Color fundus photograph; FOV: 45 degrees; 2352 x 1568 pixels.
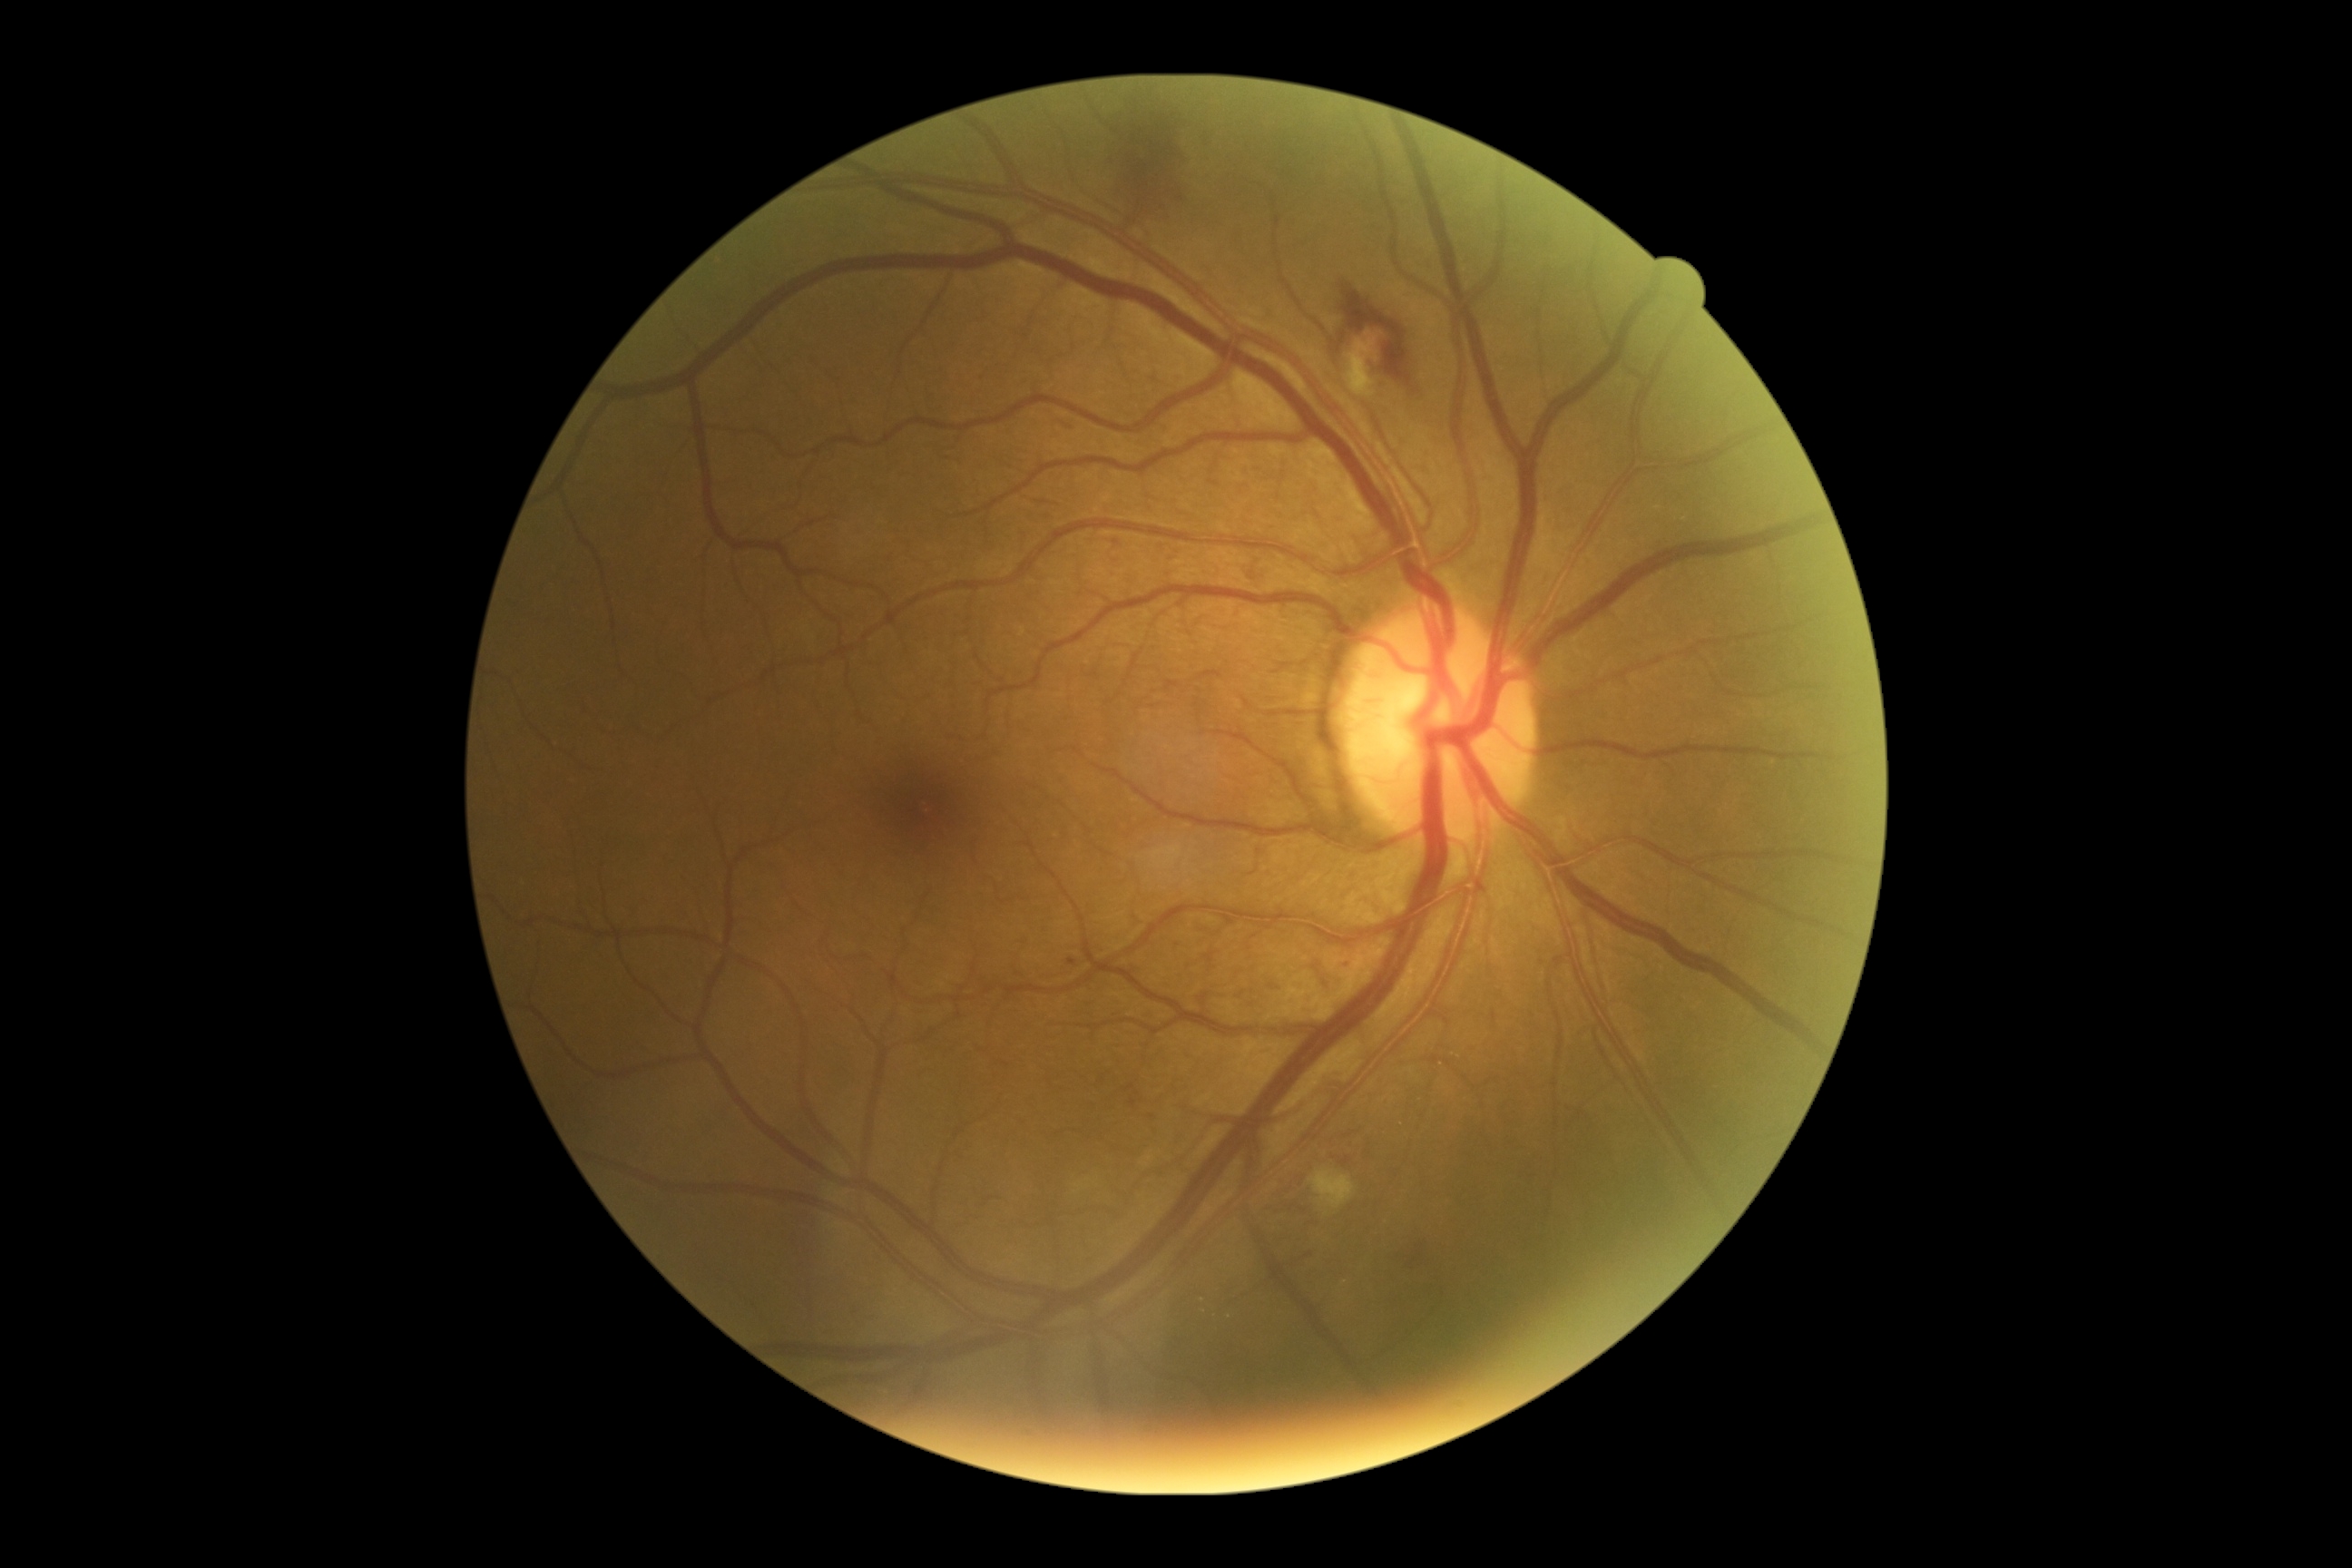

<lesions partial="true">
  <dr_grade>2</dr_grade>
  <he>box(1251, 569, 1262, 585) | box(1331, 284, 1418, 391) | box(1398, 1224, 1427, 1273) | box(1110, 104, 1193, 224)</he>
  <se partial="true">box(1344, 328, 1387, 400) | box(1309, 1170, 1355, 1210)</se>
  <se_small_approx>1327/1215 | 1151/1159 | 1080/1187</se_small_approx>
  <ex_small_approx>1204/1311 | 1202/1300</ex_small_approx>
  <ma partial="true">box(1342, 1157, 1351, 1166) | box(1064, 424, 1072, 429) | box(1344, 961, 1353, 974) | box(1130, 1099, 1139, 1108) | box(1113, 540, 1121, 545) | box(1068, 959, 1077, 968)</ma>
  <ma_small_approx>1152/1117</ma_small_approx>
</lesions>